ONH-centered crop from a color fundus image.
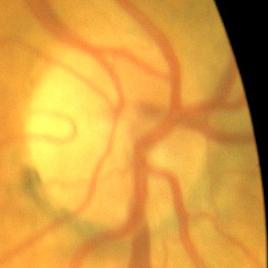
The image shows no glaucomatous damage.